45° FOV; 2352 x 1568 pixels
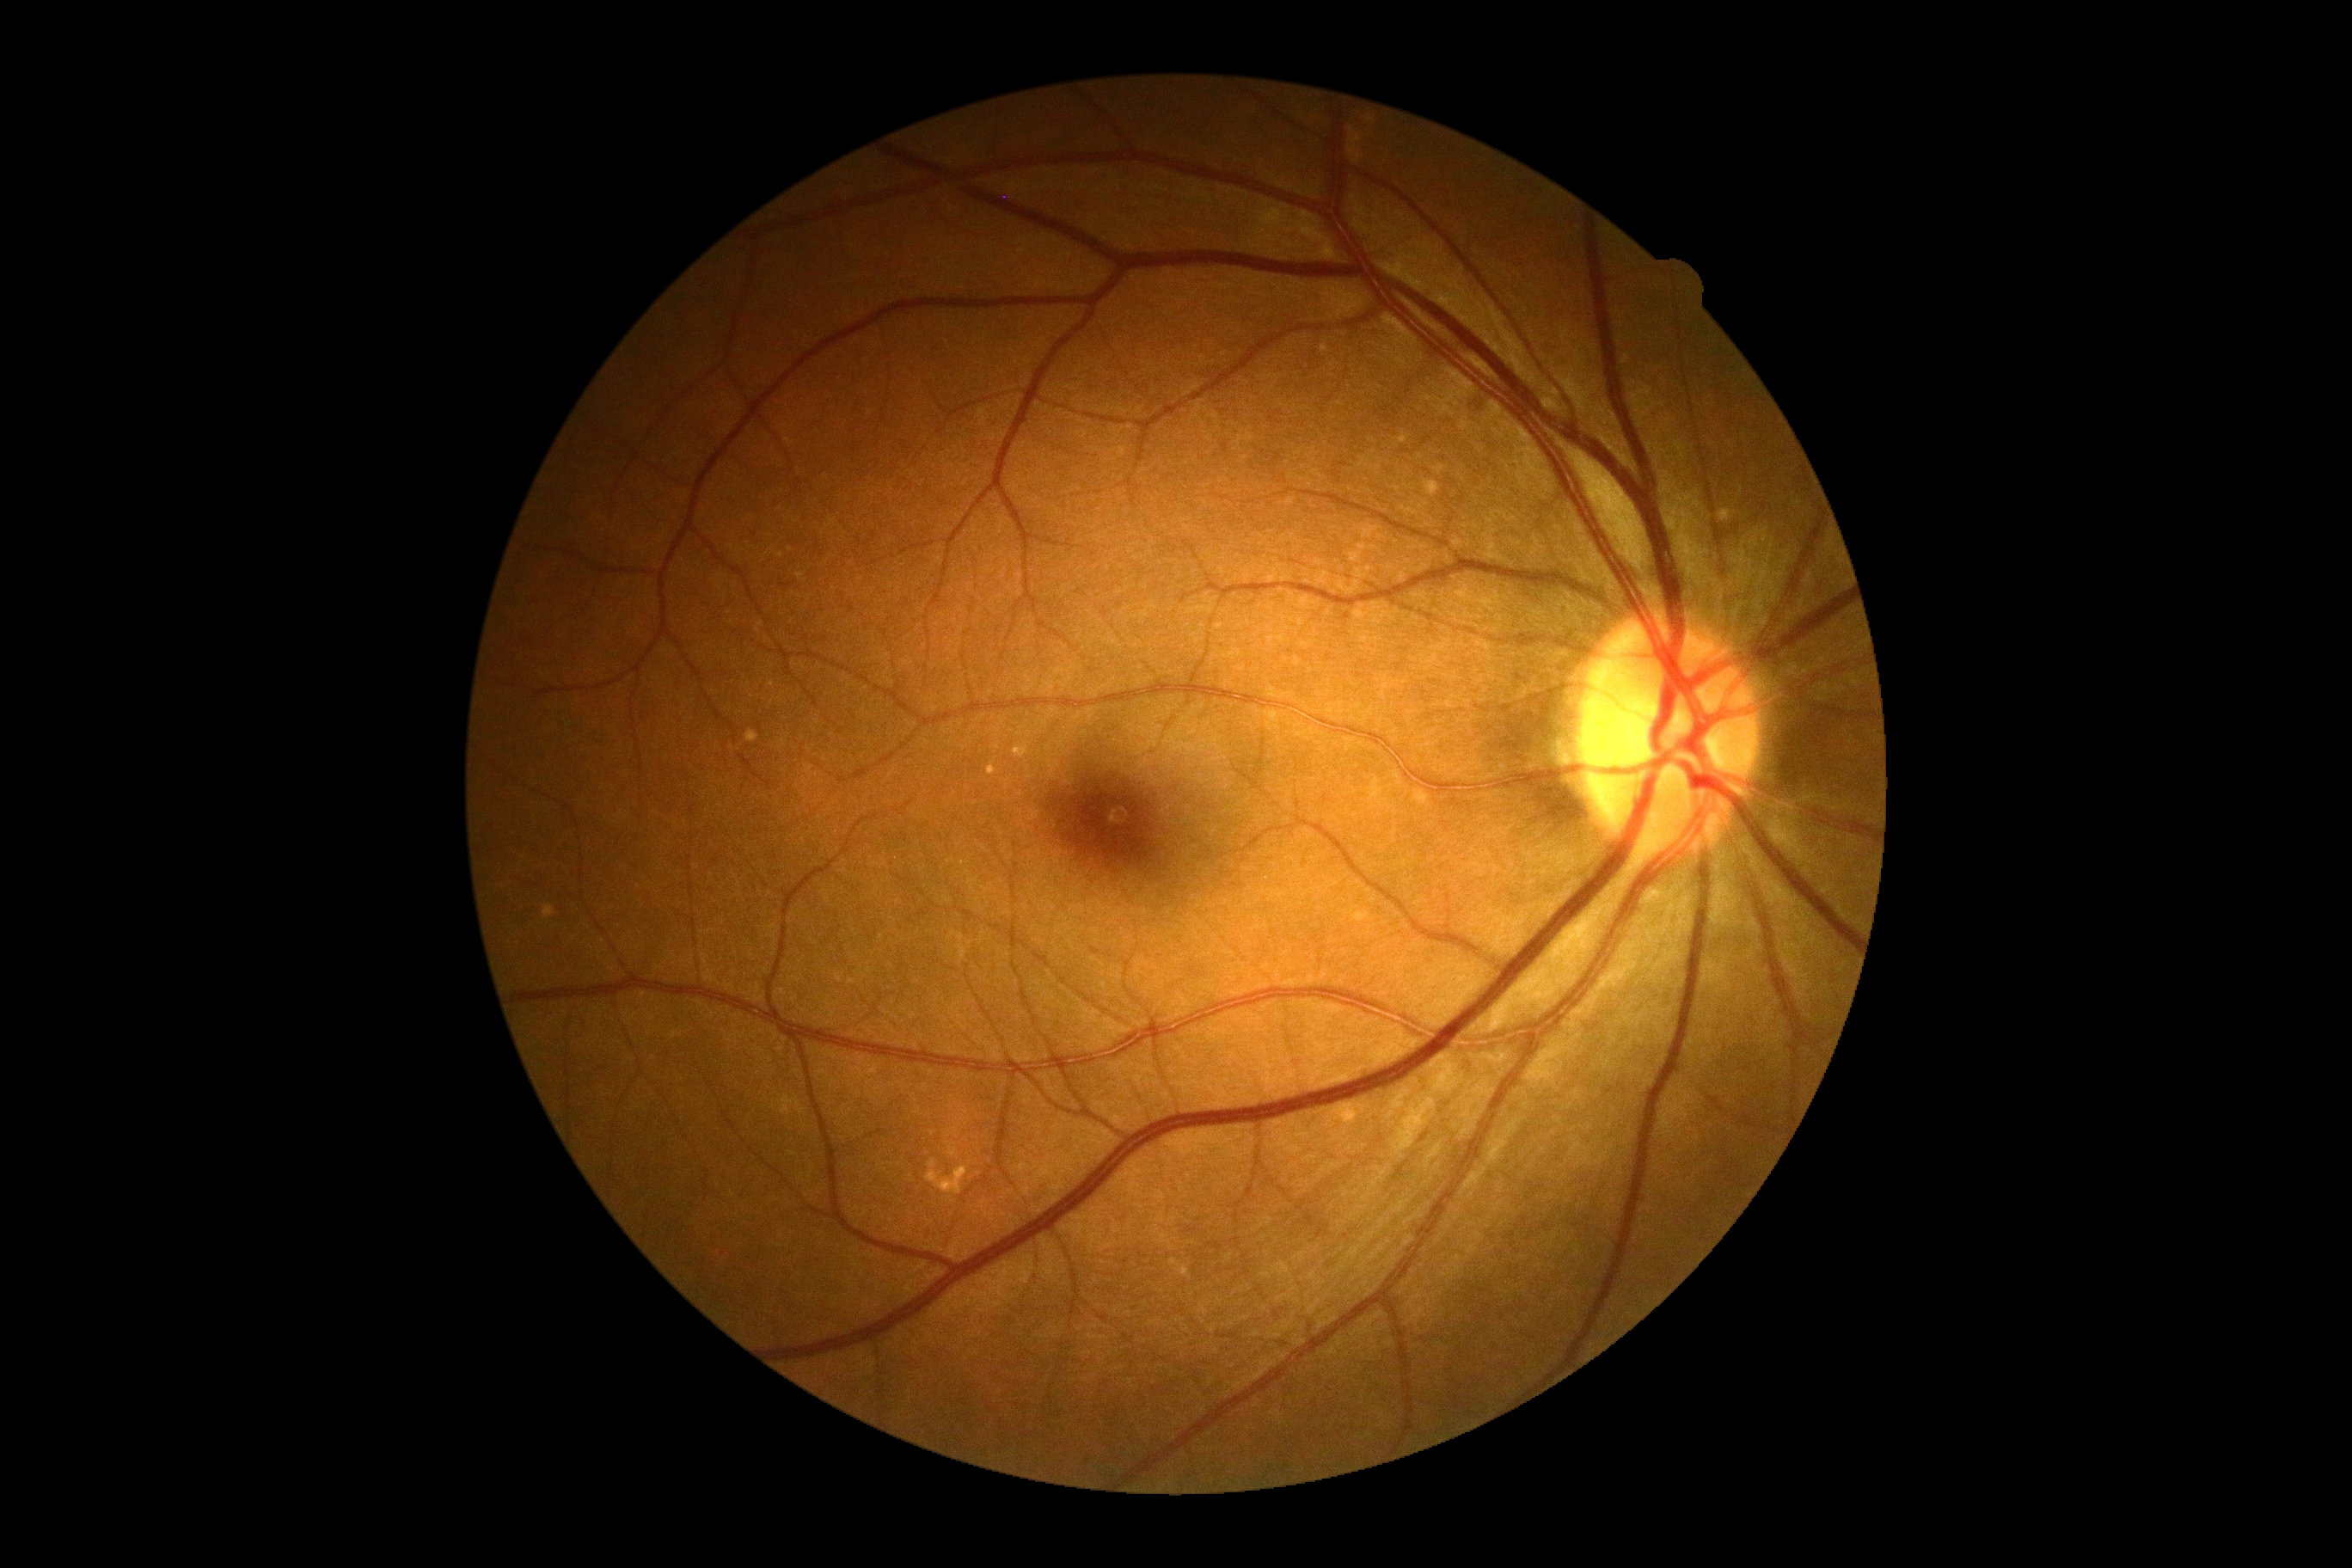 No DR findings.
DR grade is 0/4.